45° FOV · 1932 by 1916 pixels · fundus photo:
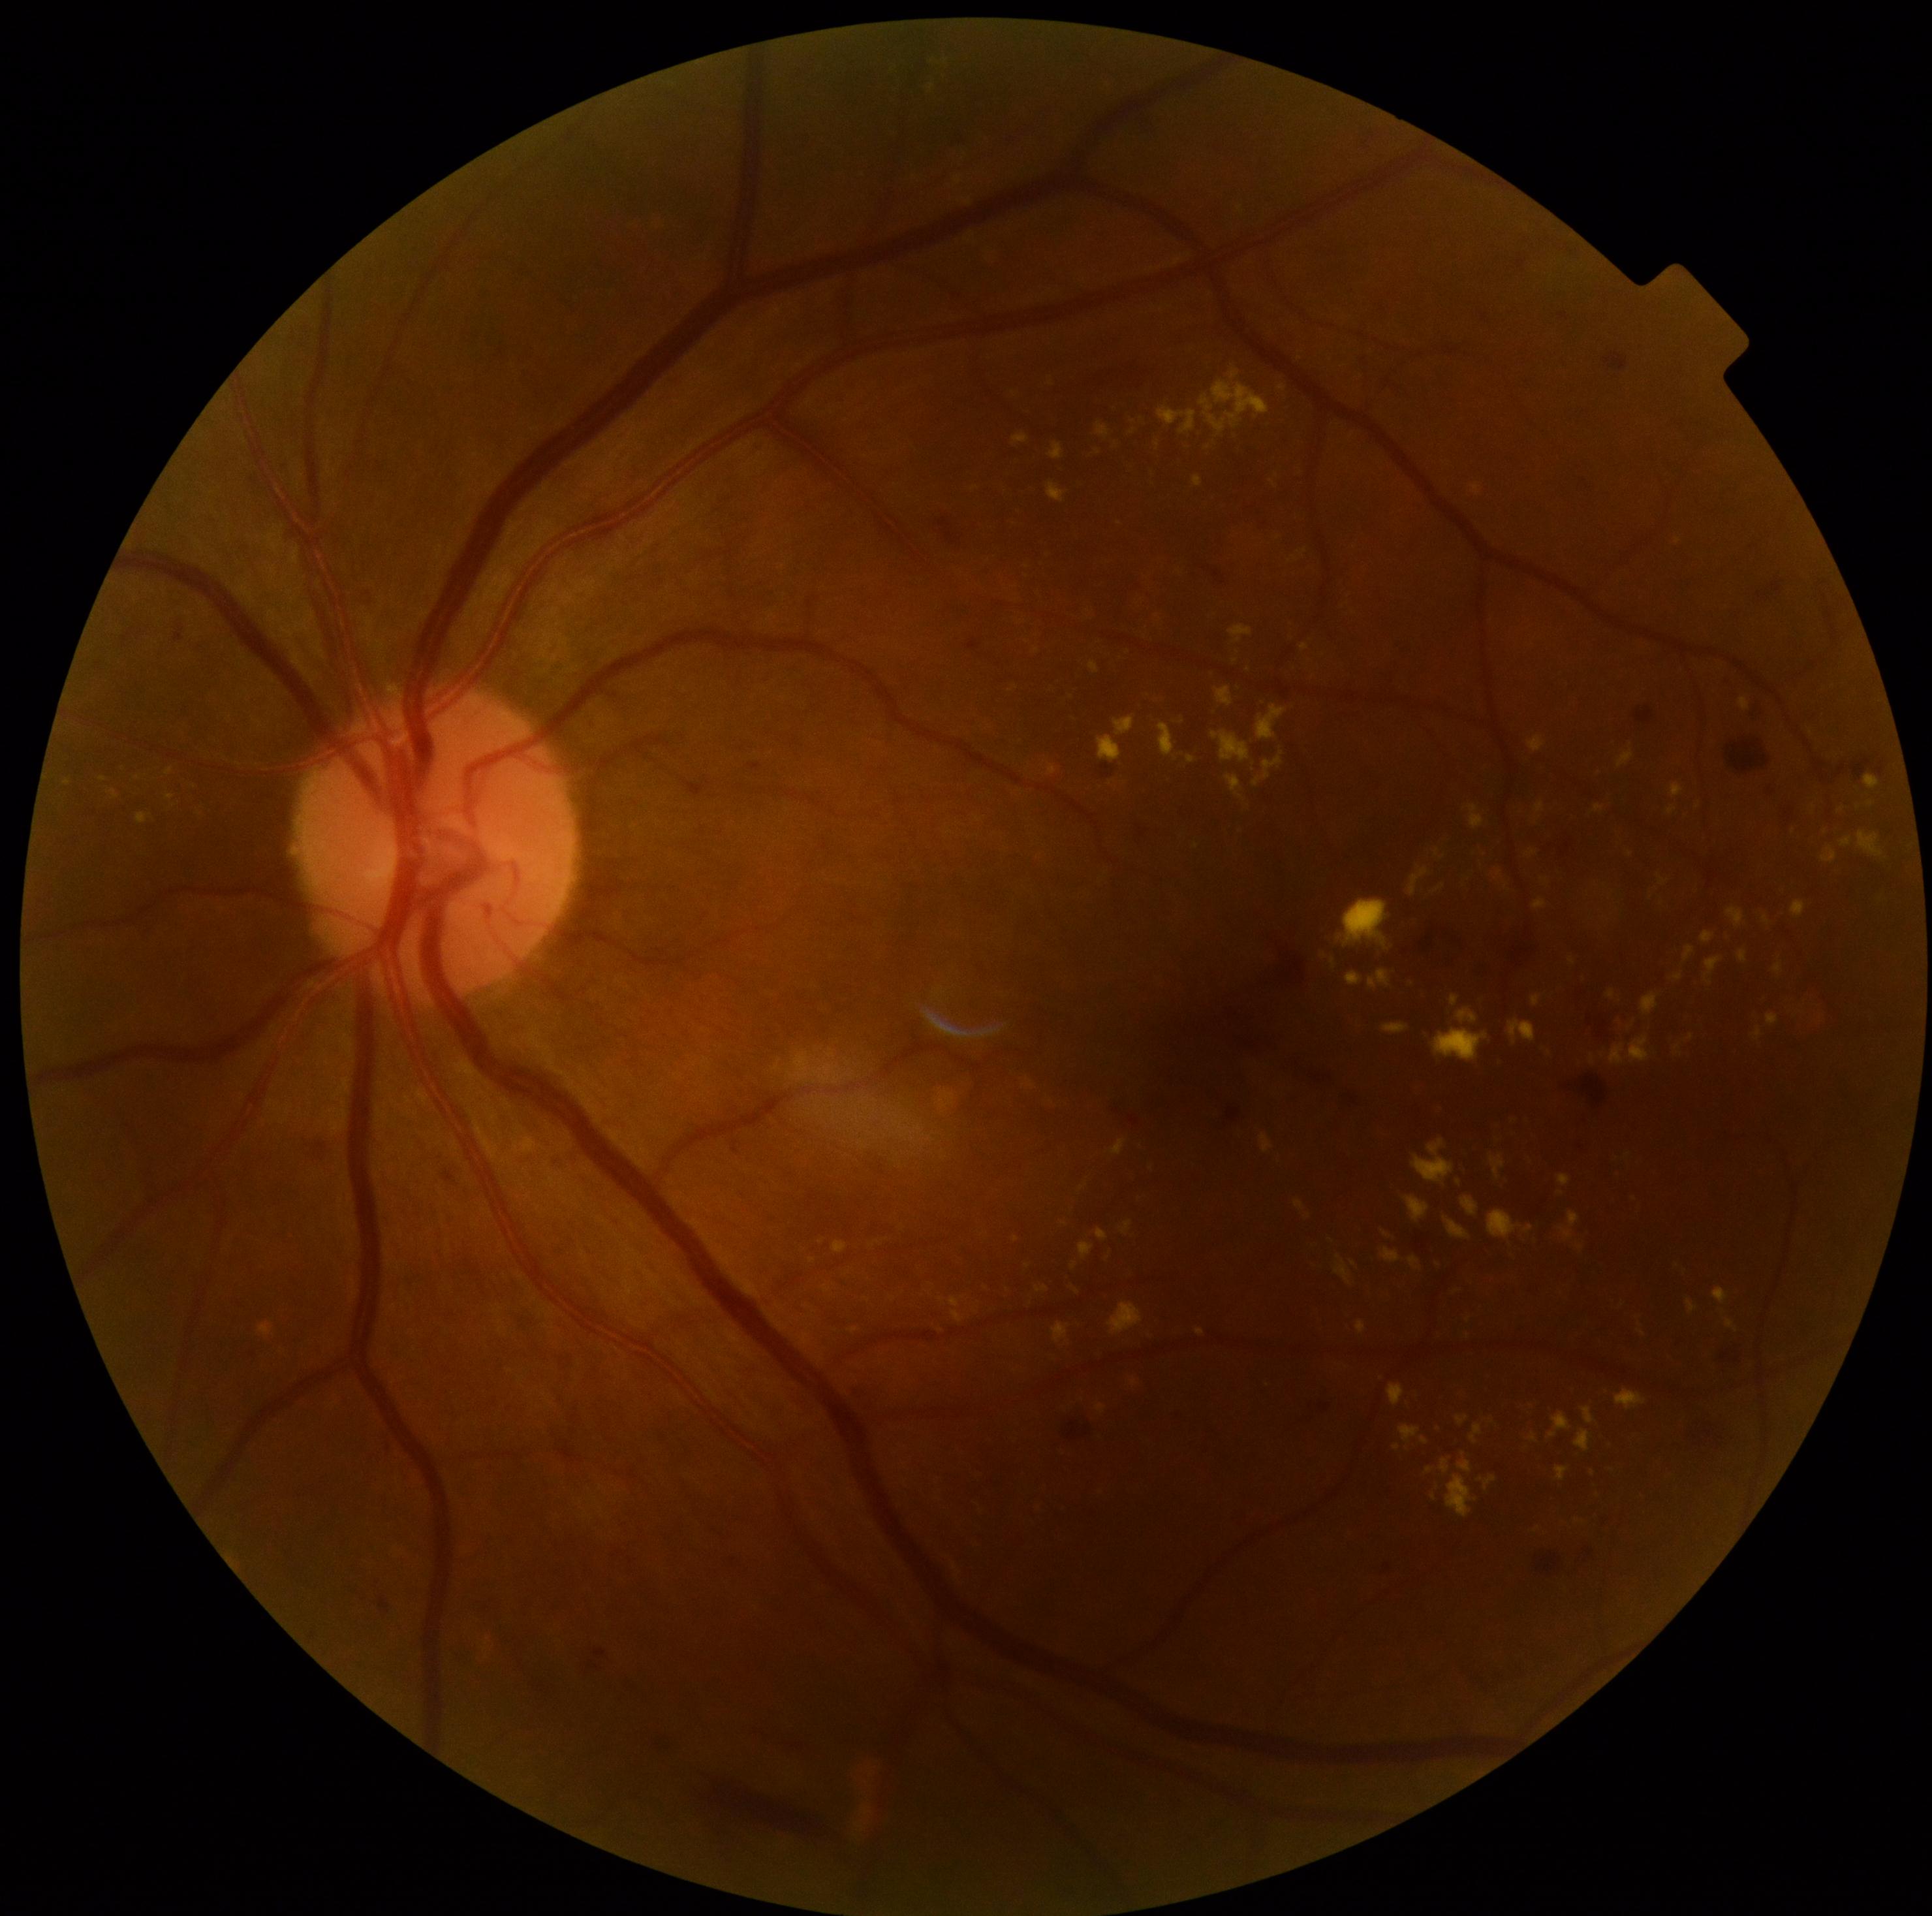

<lesions partial="true">
  <dr_grade>2</dr_grade>
  <ex partial="true">1478:1475:1498:1490; 165:768:173:776; 1337:898:1391:950; 1409:1257:1422:1270; 1072:1261:1078:1269; 1096:423:1109:440; 1446:1217:1471:1239; 1576:1430:1592:1452; 1488:1209:1521:1239; 1037:1286:1049:1294; 1738:950:1747:964; 1642:994:1660:1016; 1531:995:1542:1007</ex>
  <ex_small_approx><point>1841, 810</point>; <point>1308, 1218</point>; <point>1119, 523</point>; <point>1631, 853</point>; <point>1282, 388</point>; <point>174, 805</point></ex_small_approx>
  <he partial="true">1537:1552:1563:1573; 1720:1329:1749:1372; 1604:354:1628:371; 1273:1052:1330:1094; 1281:947:1307:984; 1477:945:1538:977; 1102:764:1112:772; 1678:1418:1722:1453; 507:1639:554:1710; 938:518:961:546; 1559:838:1574:859</he>
</lesions>